848x848px · posterior pole color fundus photograph.
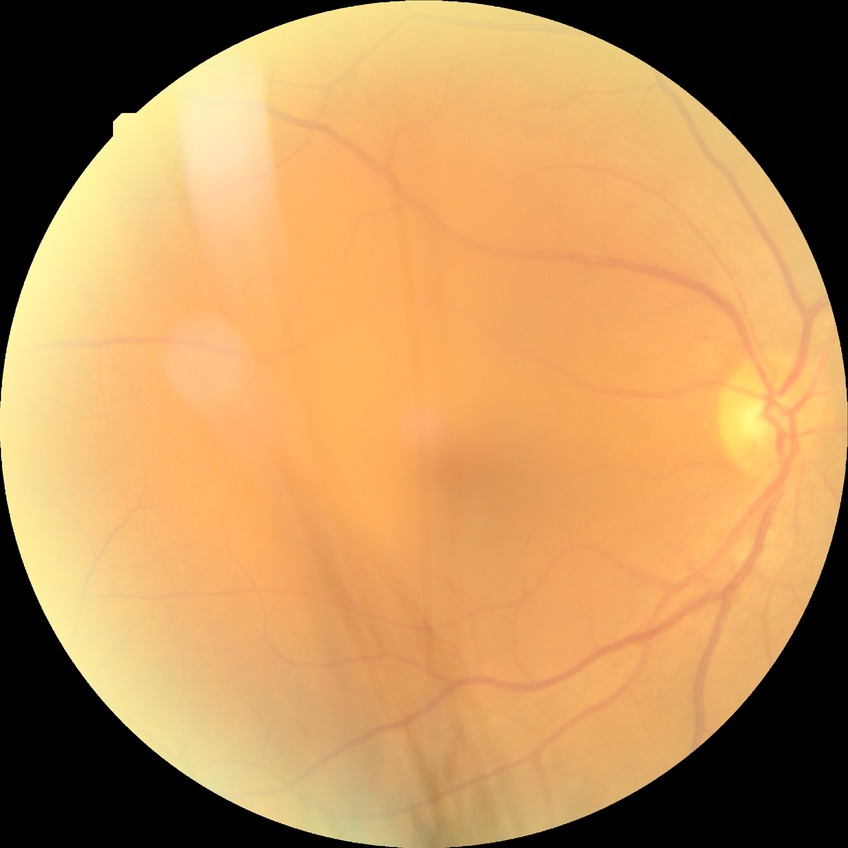 {
  "davis_grade": "SDR (simple diabetic retinopathy)"
}